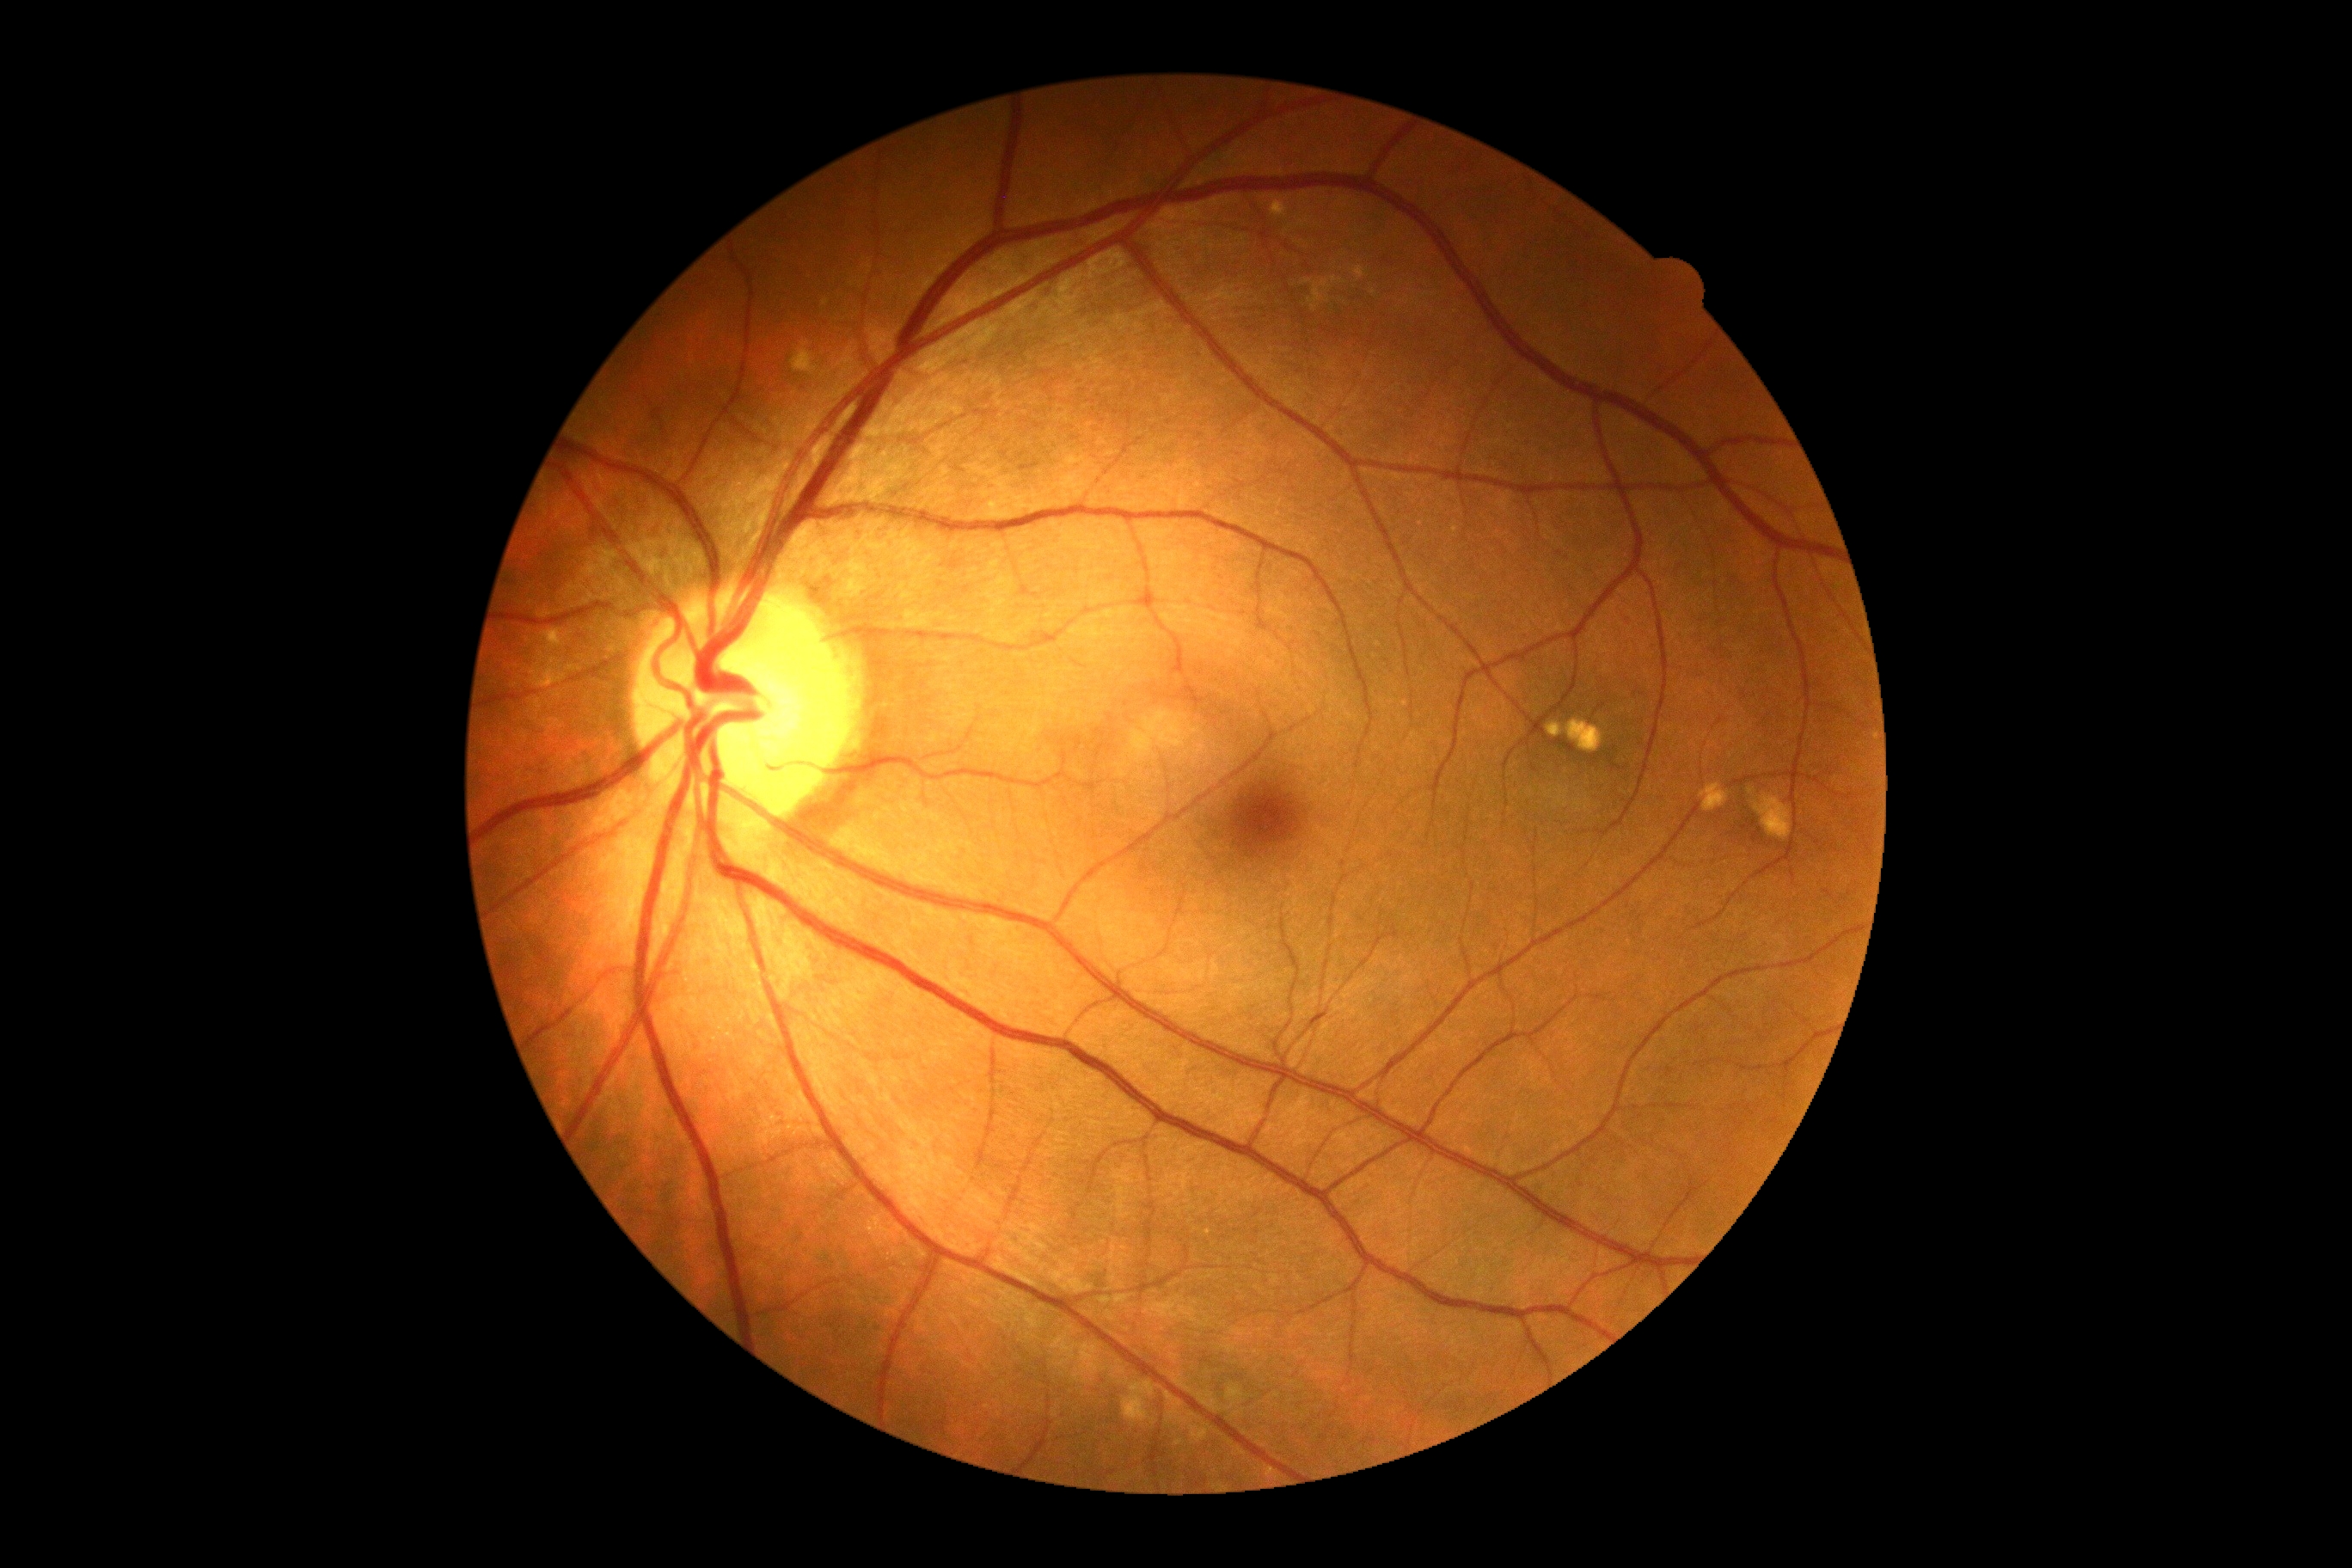

DR stage: no apparent retinopathy (grade 0).